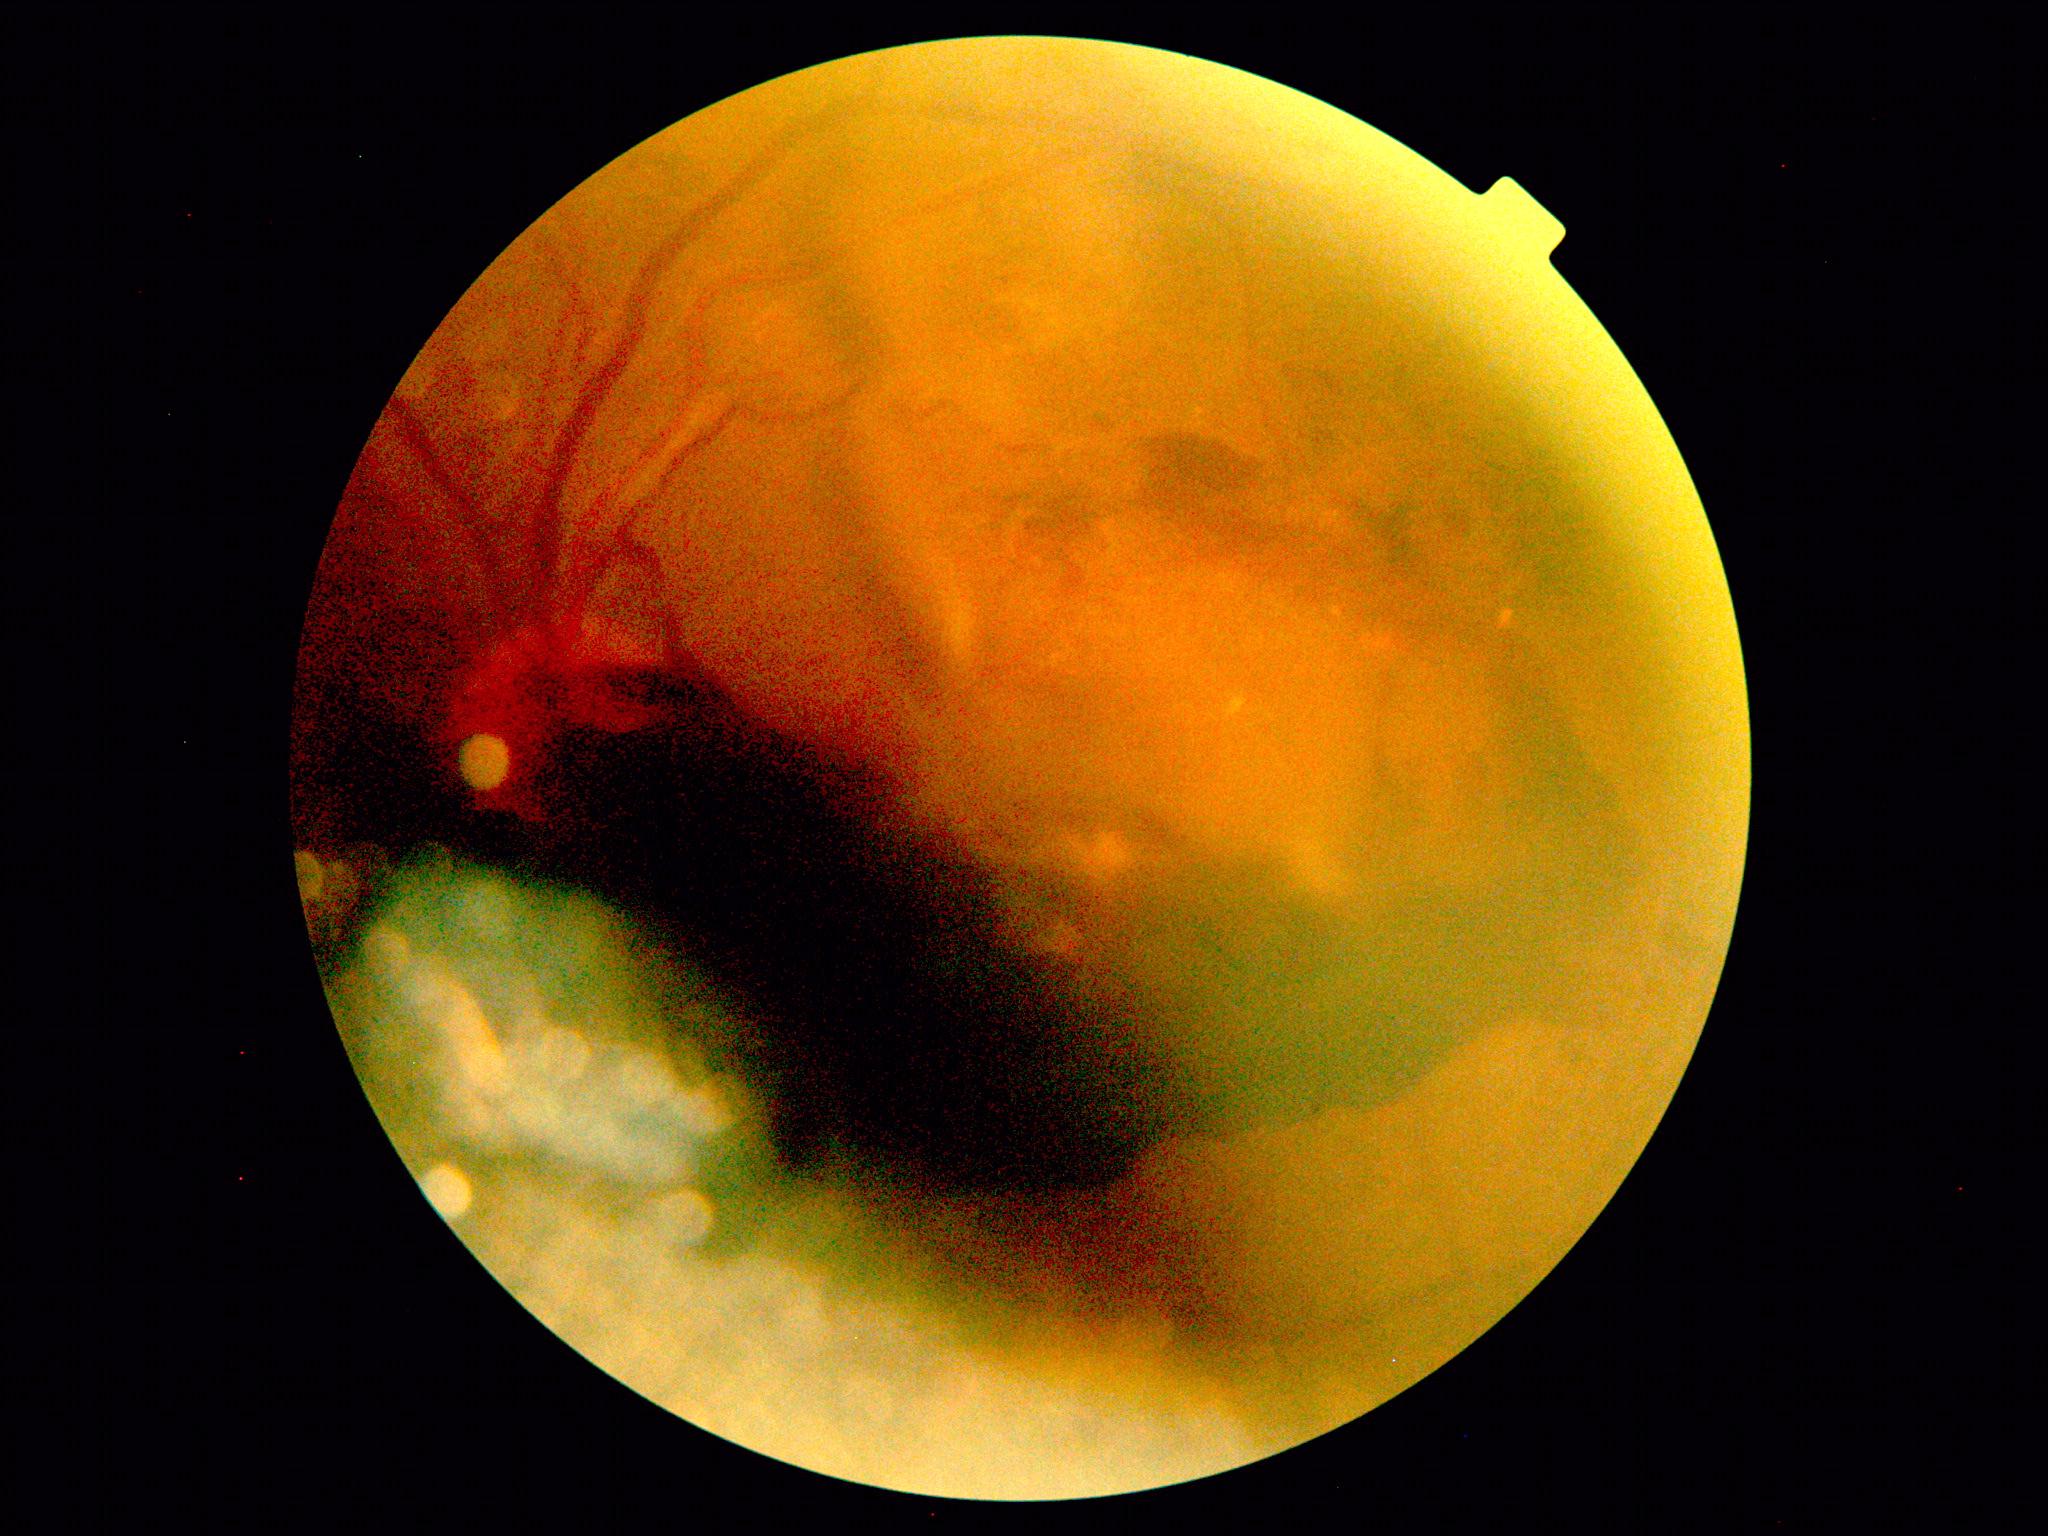

Diabetic retinopathy severity is grade 4 (PDR).